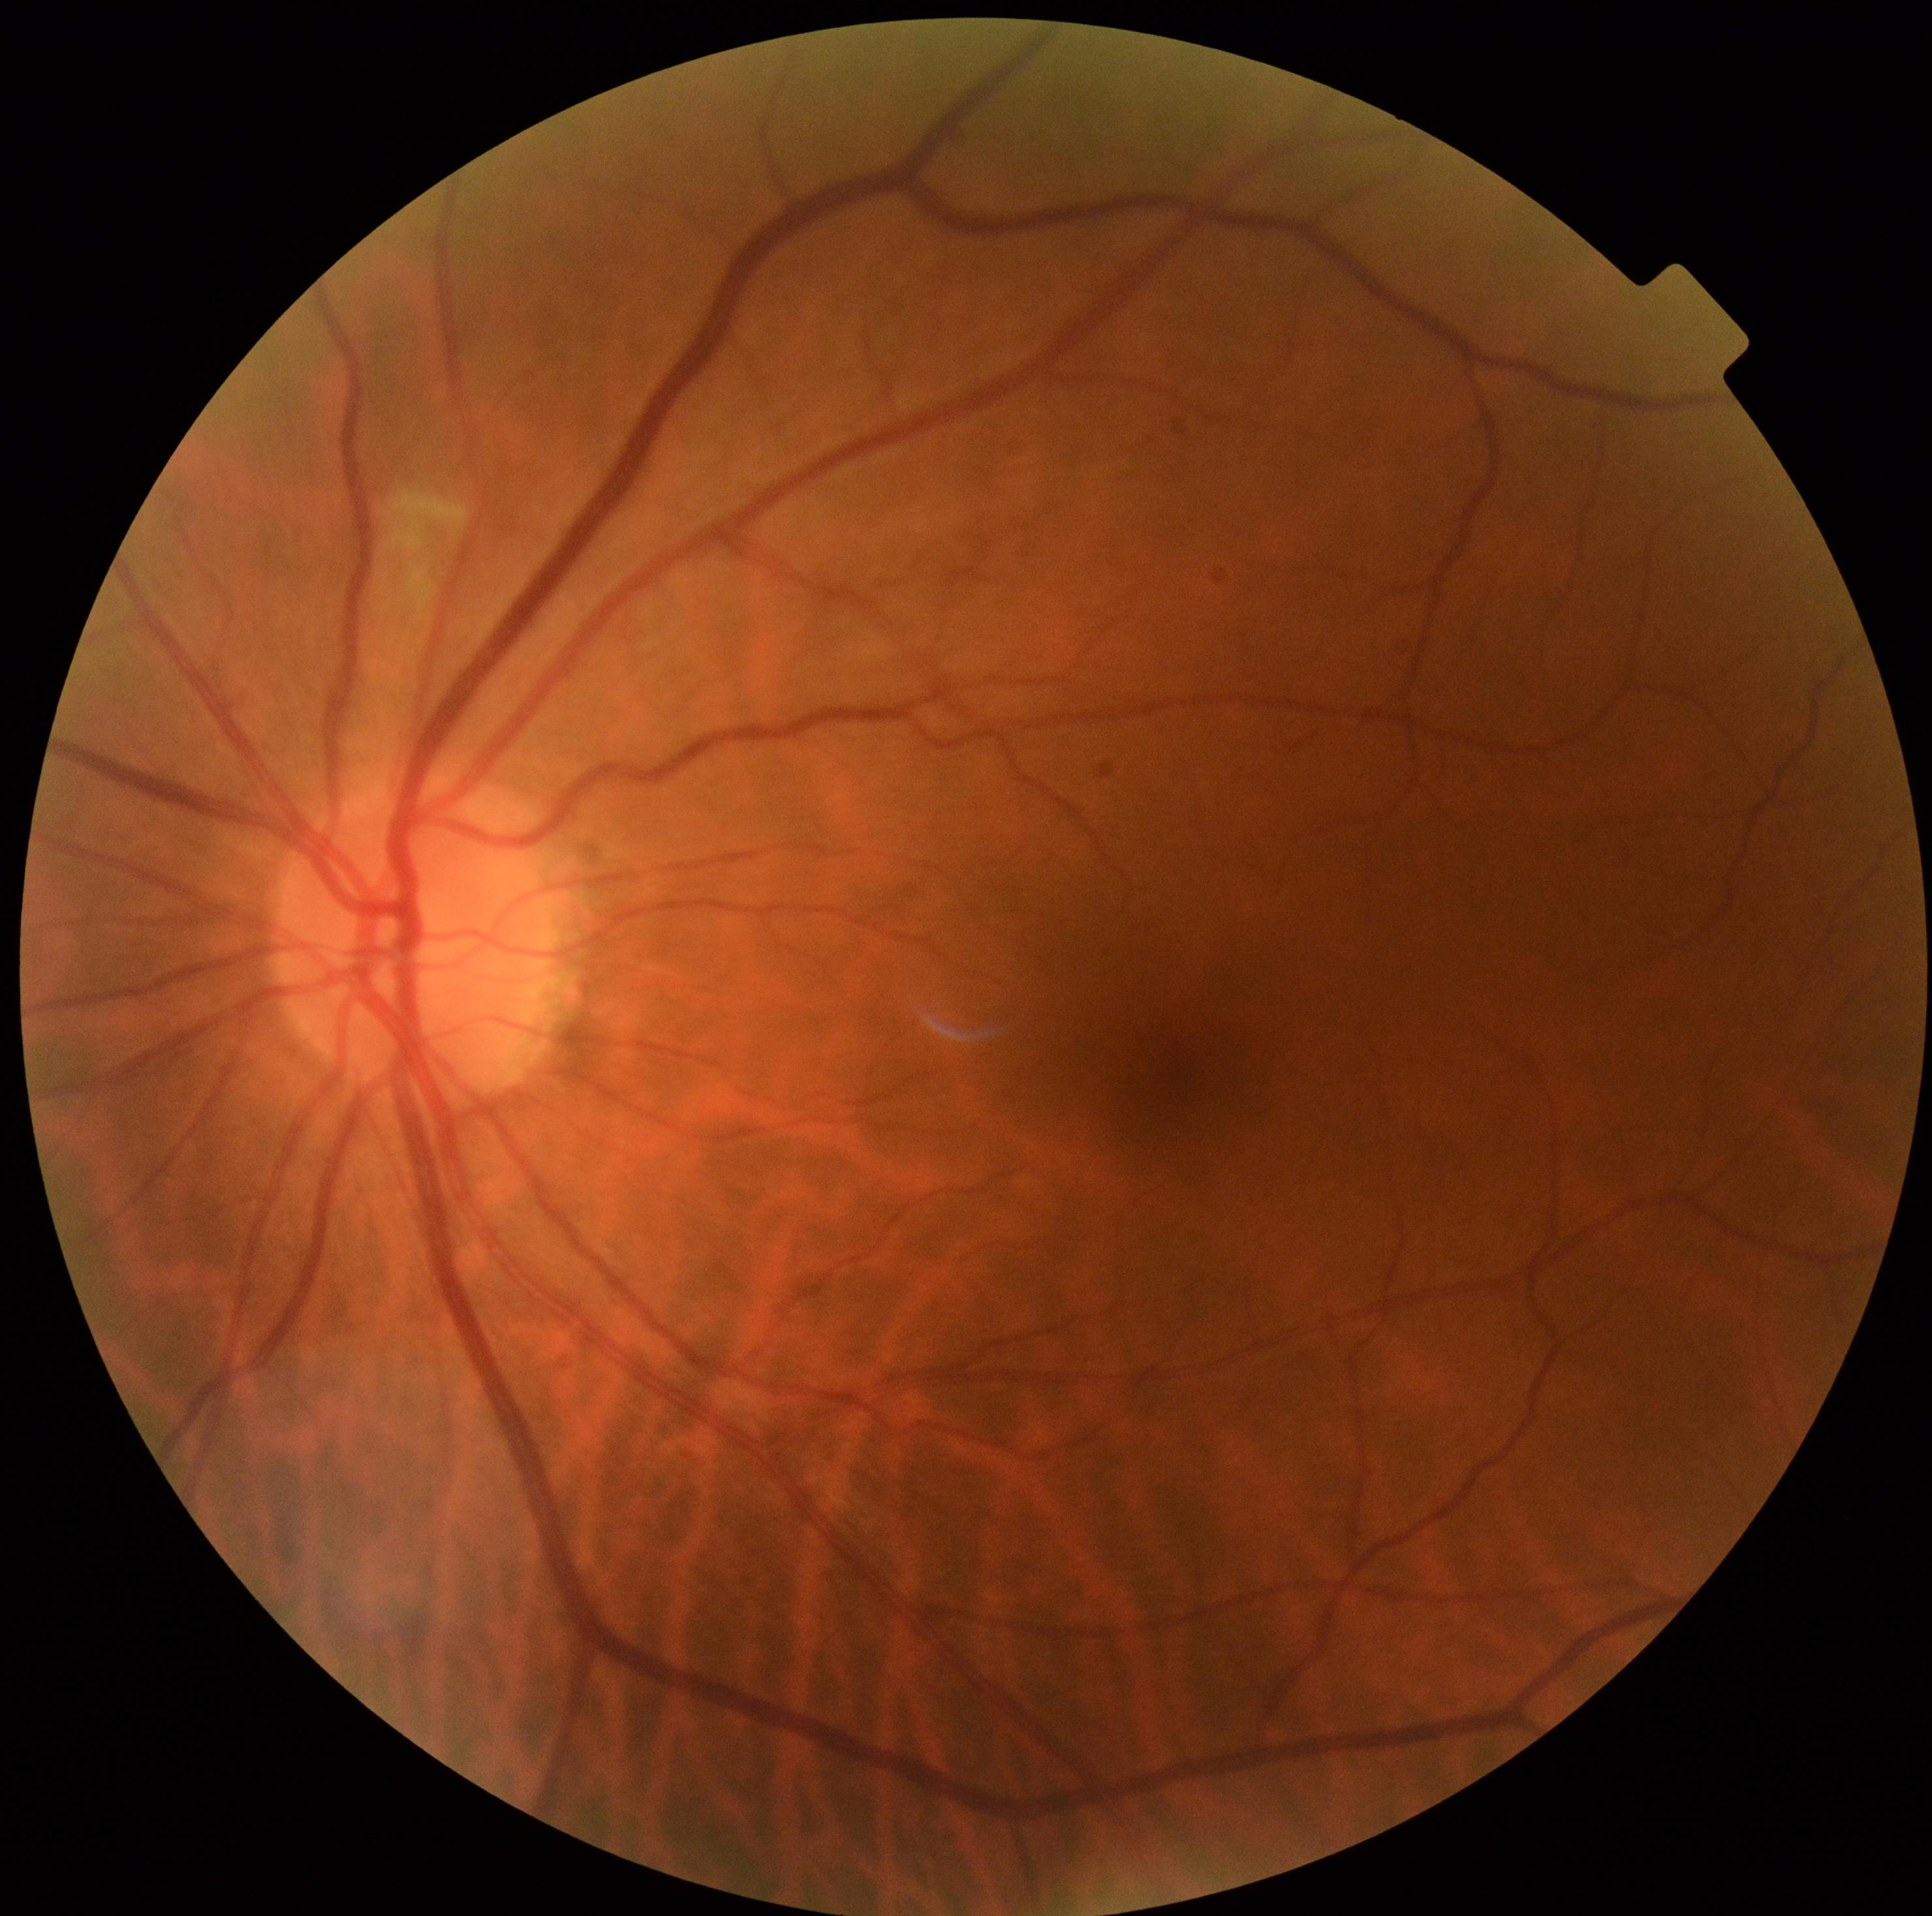
dr_category: non-proliferative diabetic retinopathy
dr_grade: 2 (moderate NPDR)